Diabetic retinopathy graded by the modified Davis classification; 45-degree field of view; 848x848 — 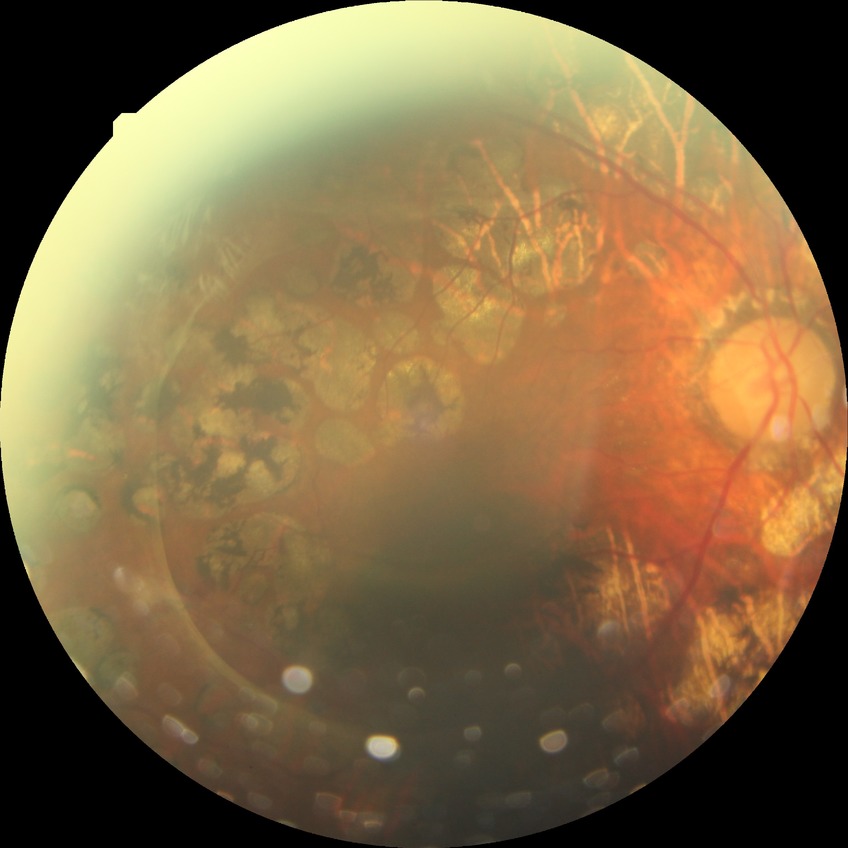 DR severity: PDR.